Posterior pole color fundus photograph. 848x848. Without pupil dilation.
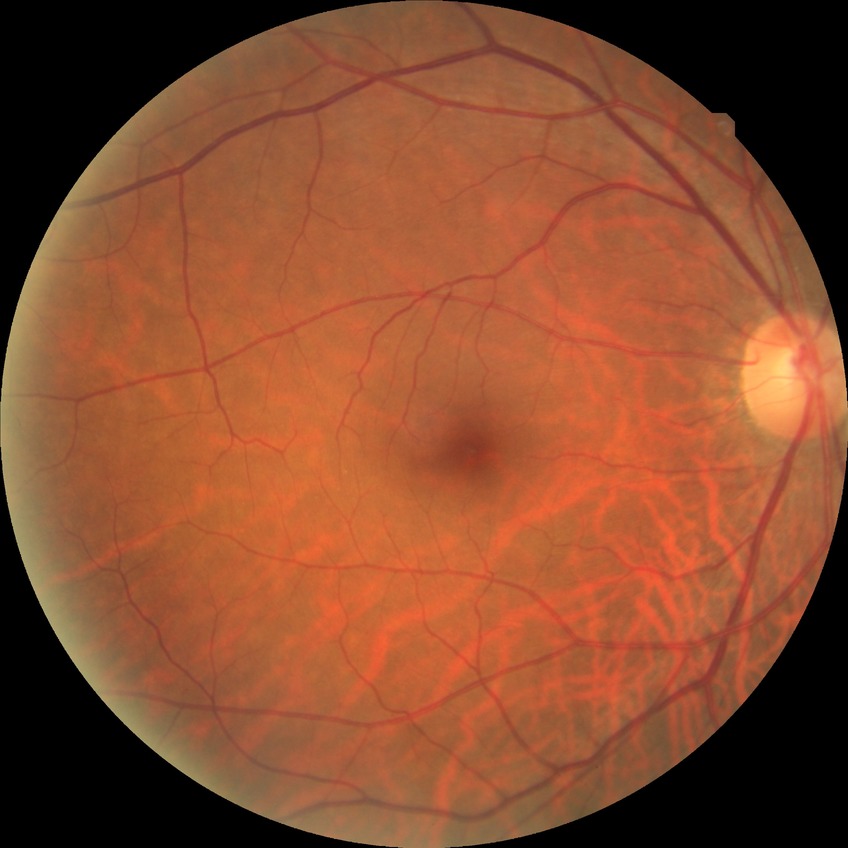 {
  "davis_grade": "no diabetic retinopathy"
}